Graded on the modified Davis scale
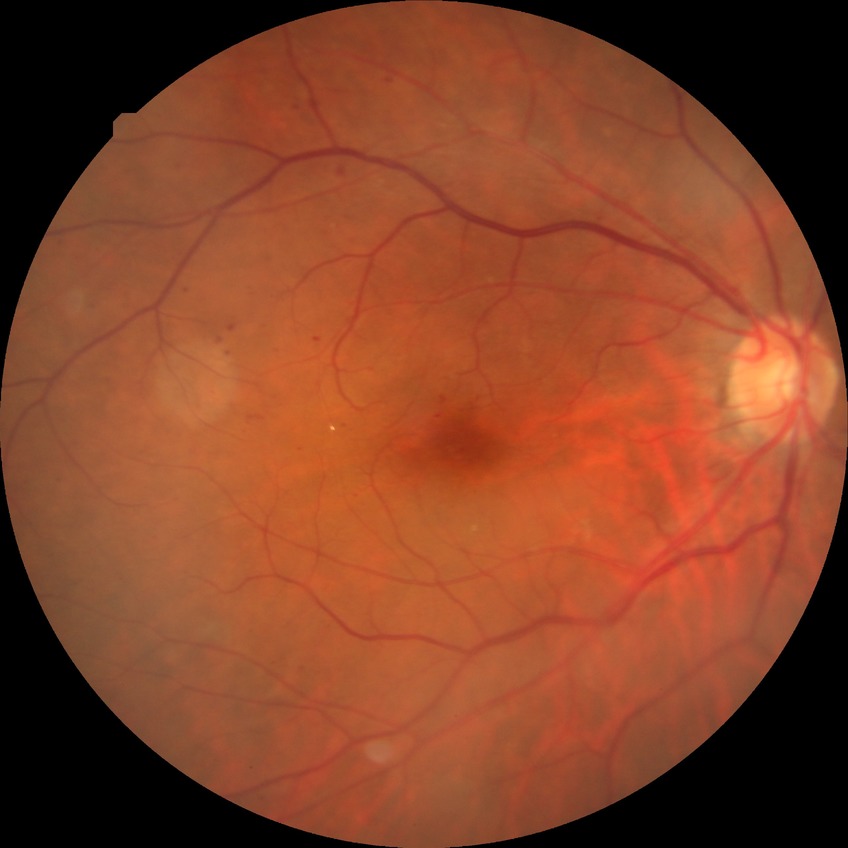

Diabetic retinopathy stage is simple diabetic retinopathy.